Fundus photo. 45° FOV. 1932 by 1932 pixels.
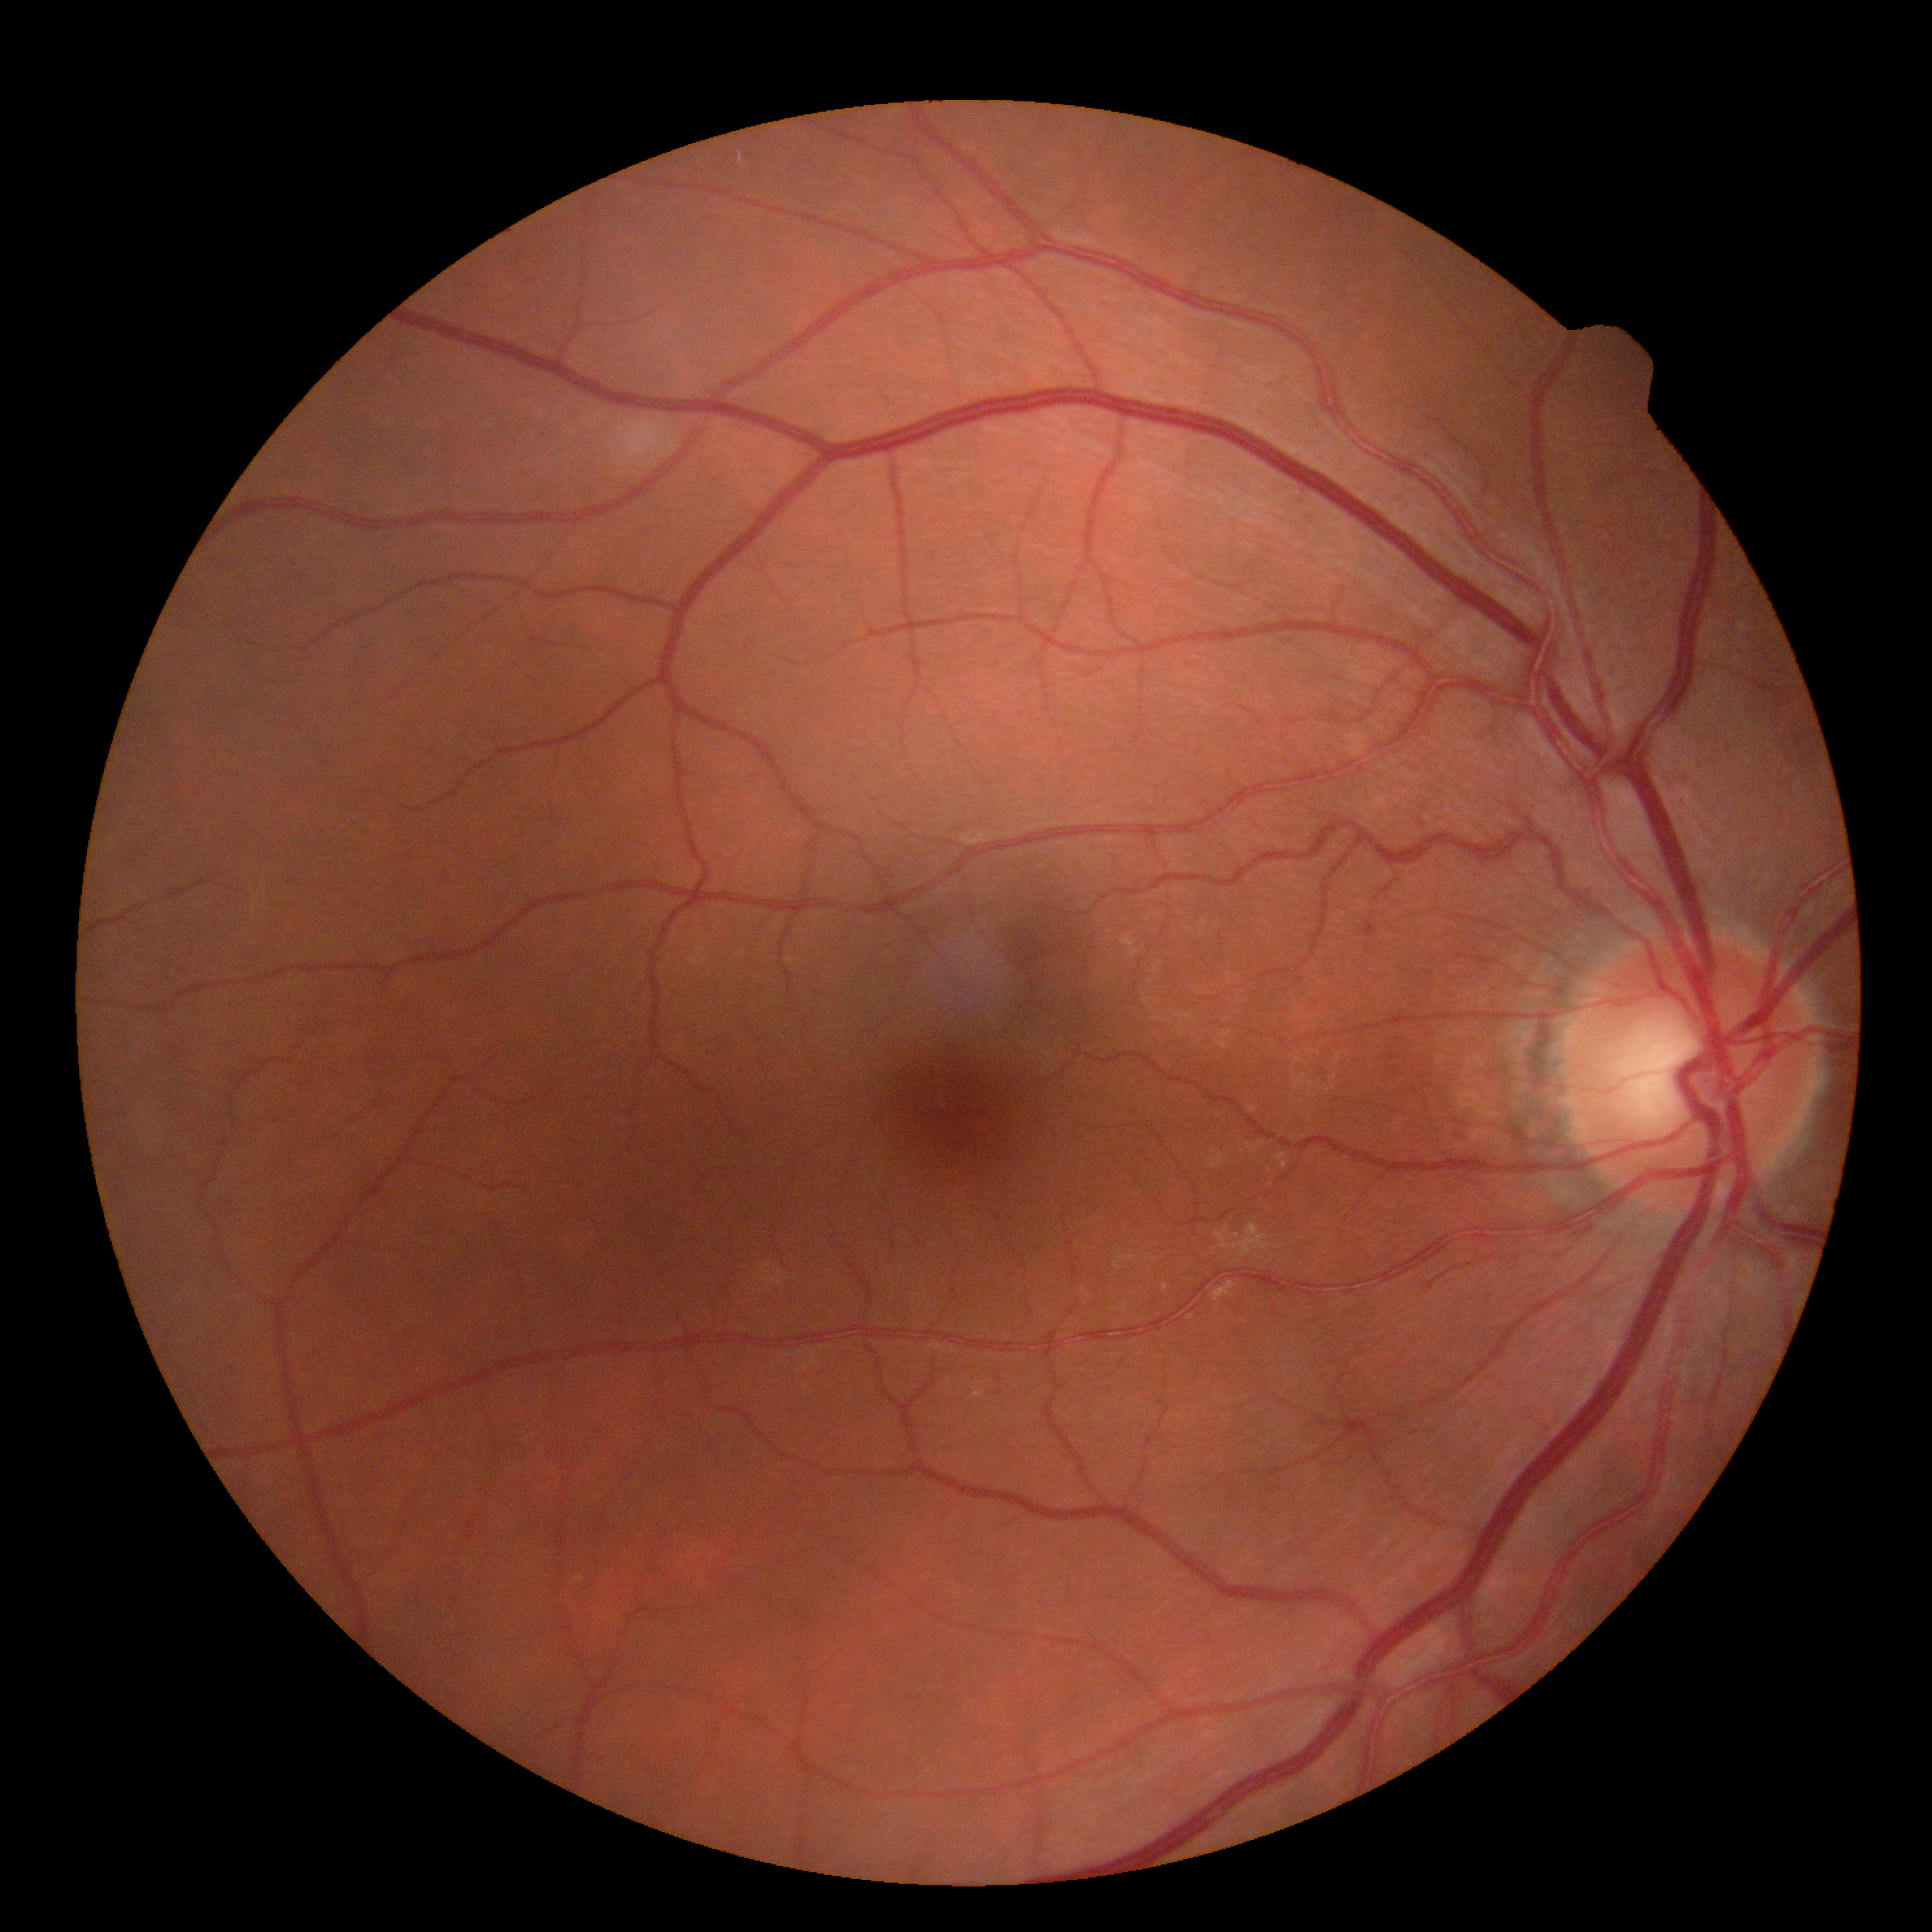

No apparent diabetic retinopathy. DR: grade 0 (no apparent retinopathy).